Captured with the Phoenix ICON (100° field of view); infant wide-field retinal image
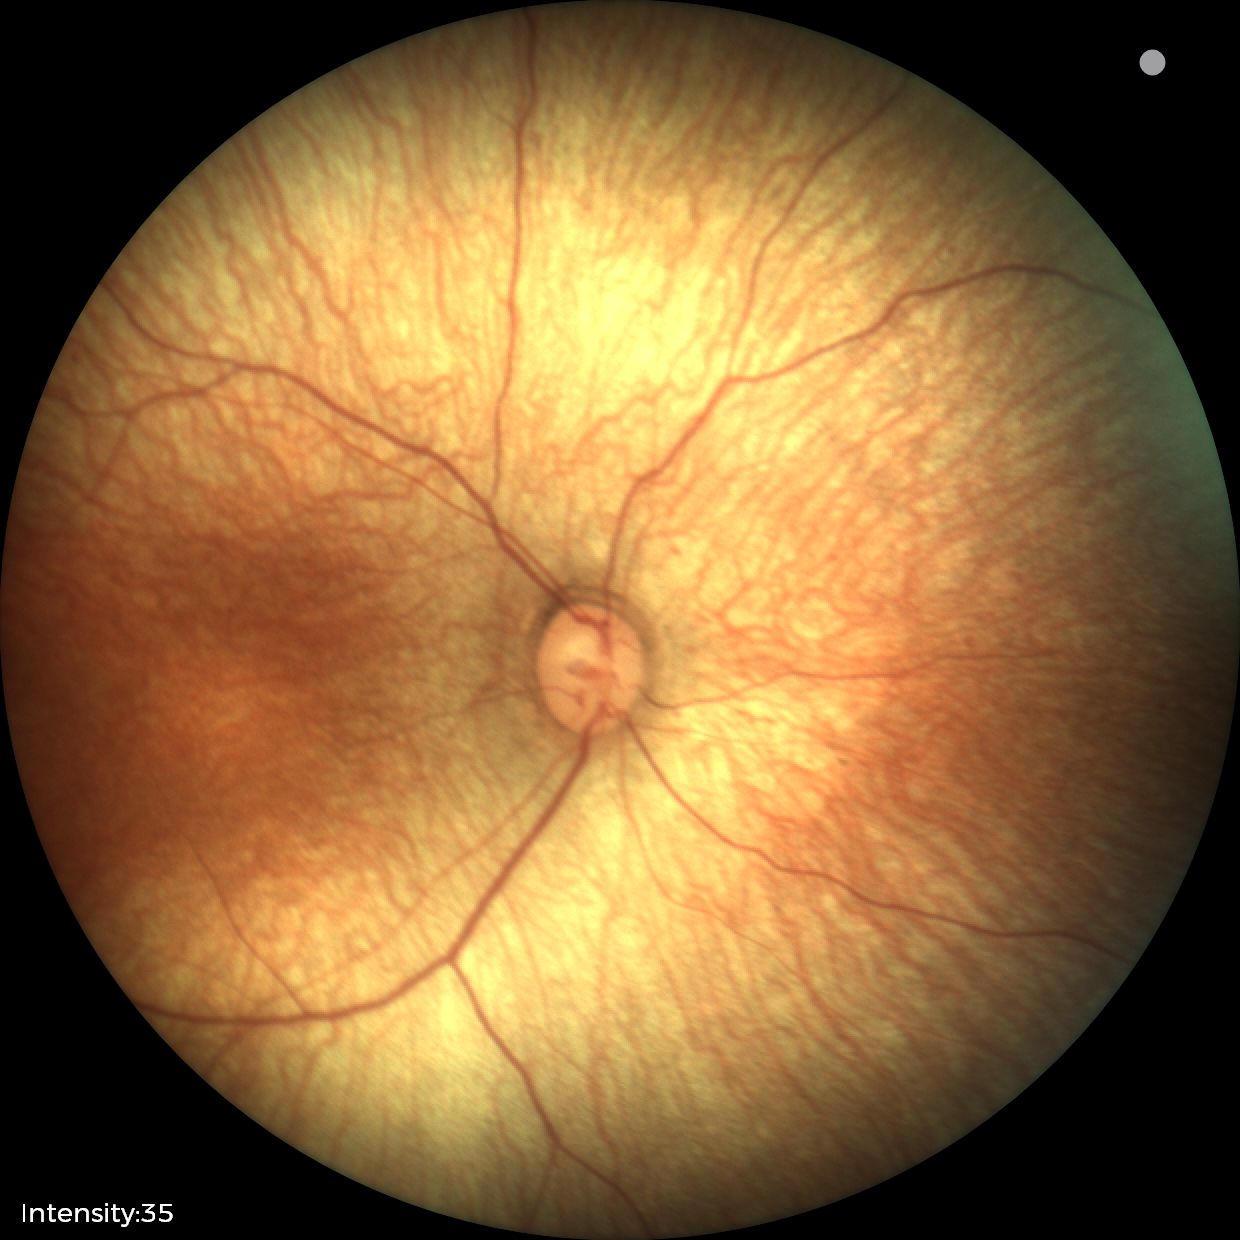
Screening diagnosis: normal fundus examination.